Image size 2212x1659; FOV: 45 degrees:
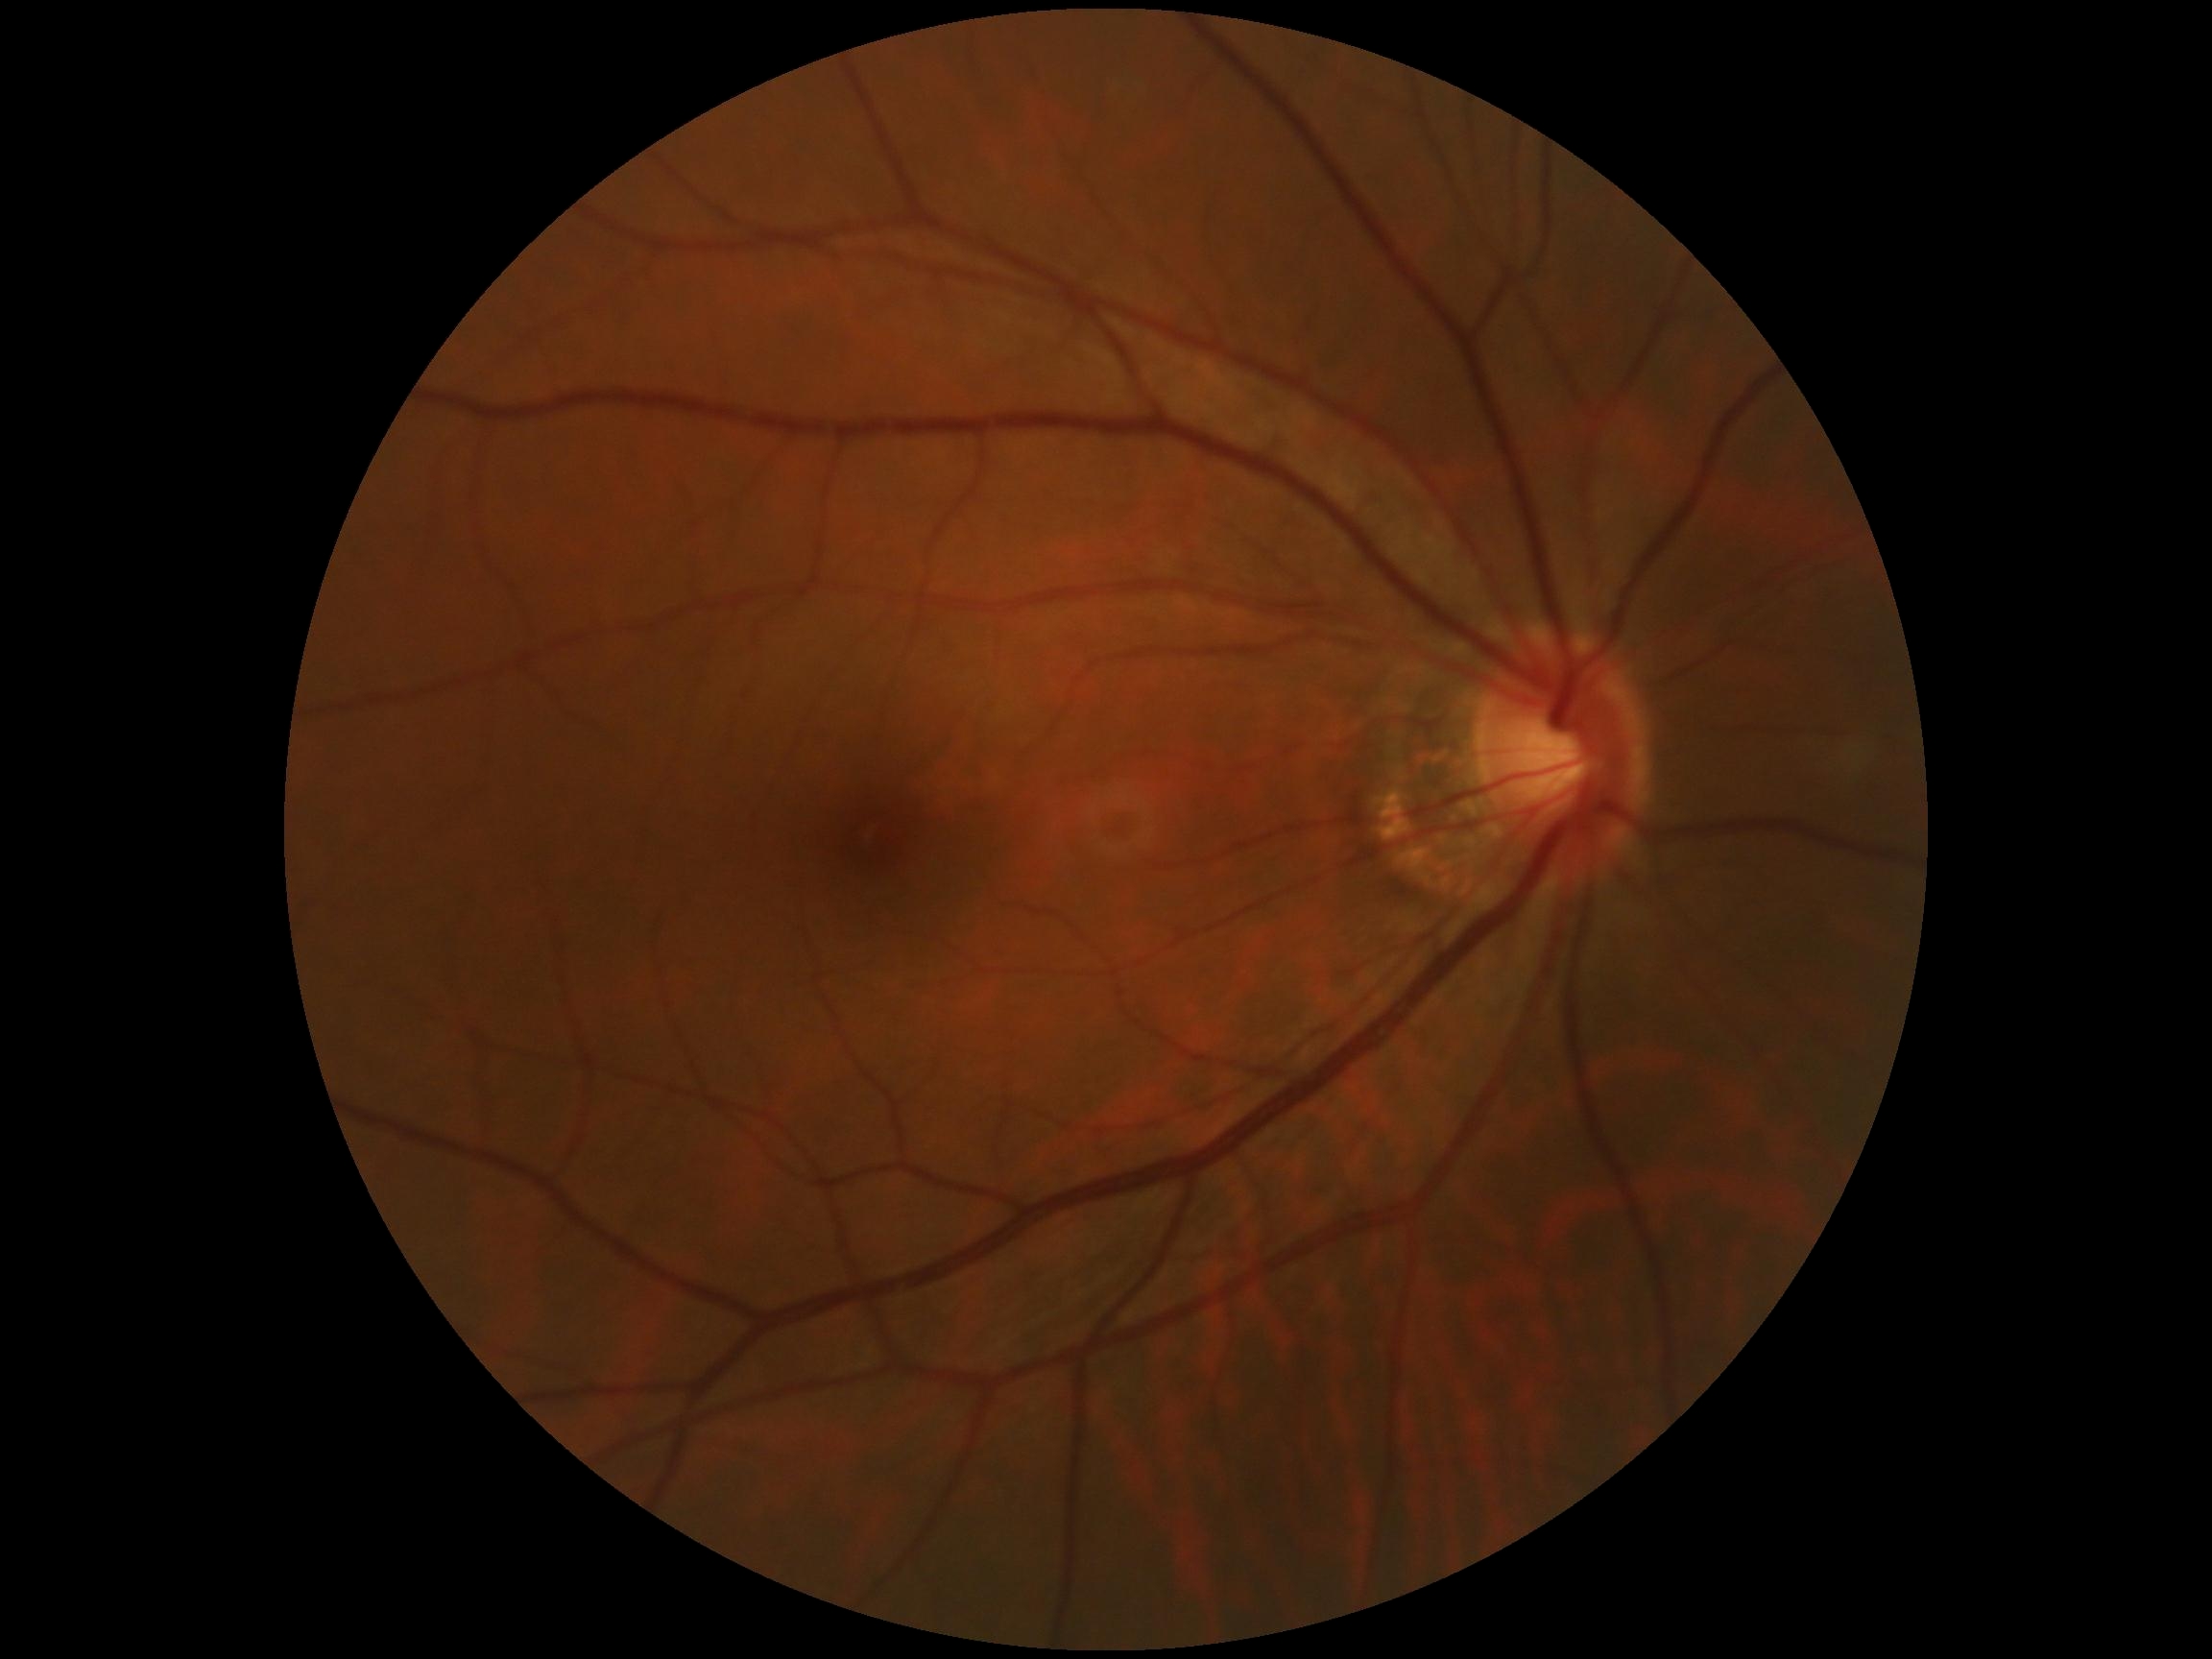
{"dr_grade": "no apparent diabetic retinopathy (grade 0)"}